Nonmydriatic fundus photograph; retinal fundus photograph; 848 x 848 pixels; FOV: 45 degrees; acquired with a NIDEK AFC-230:
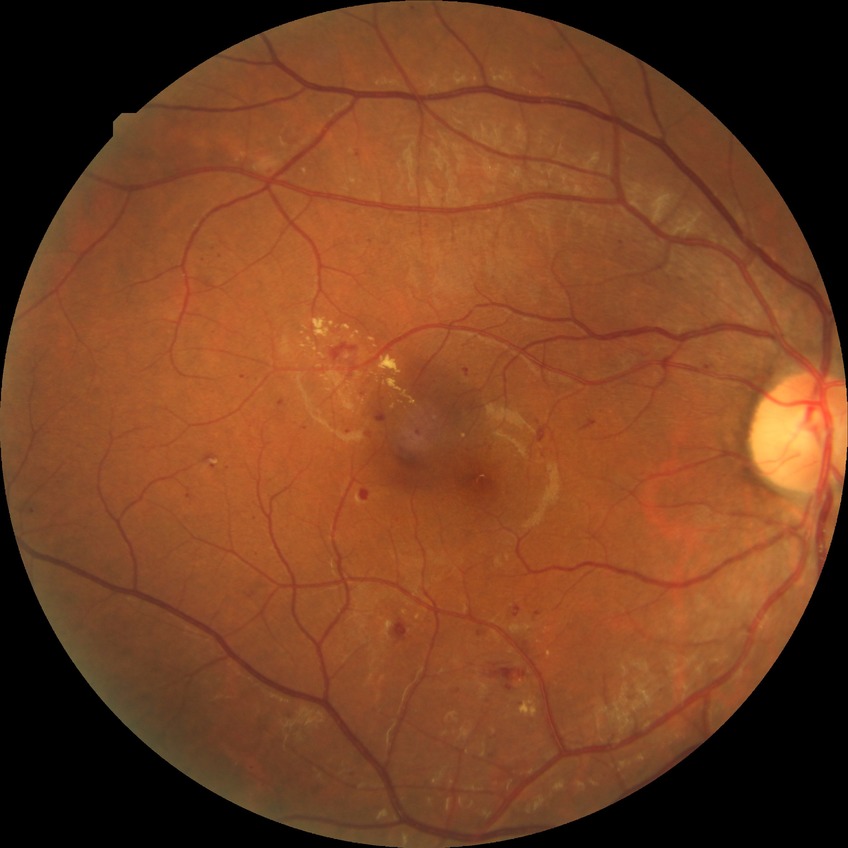
{
  "davis_grade": "SDR"
}